848x848
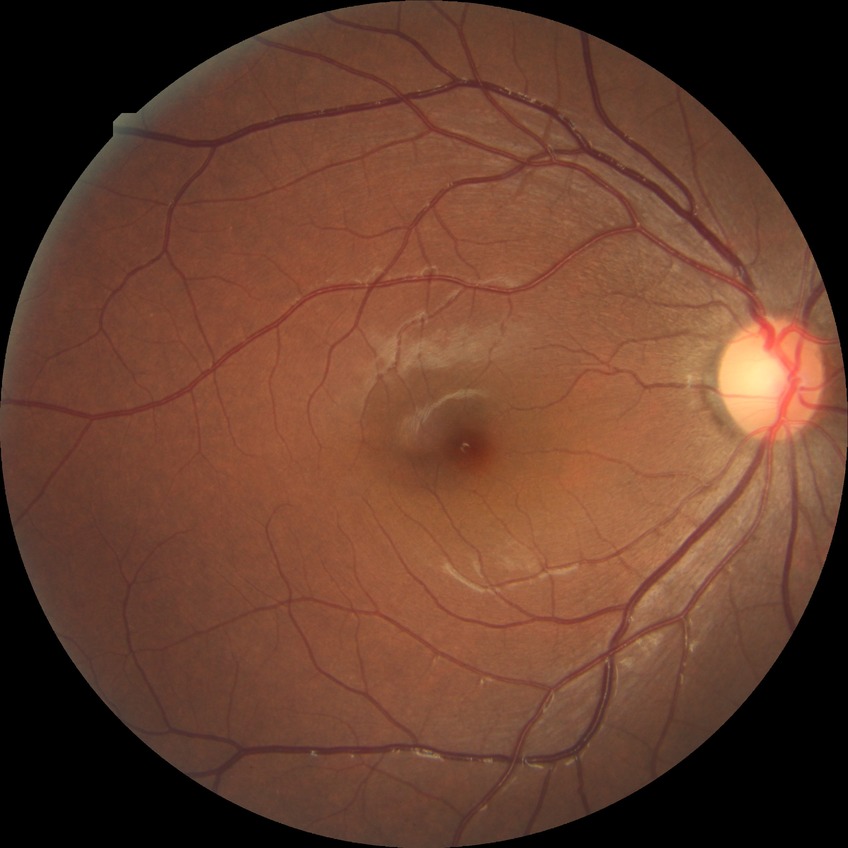

  davis_grade: no diabetic retinopathy